1725 x 1721 pixels, FOV: 45 degrees:
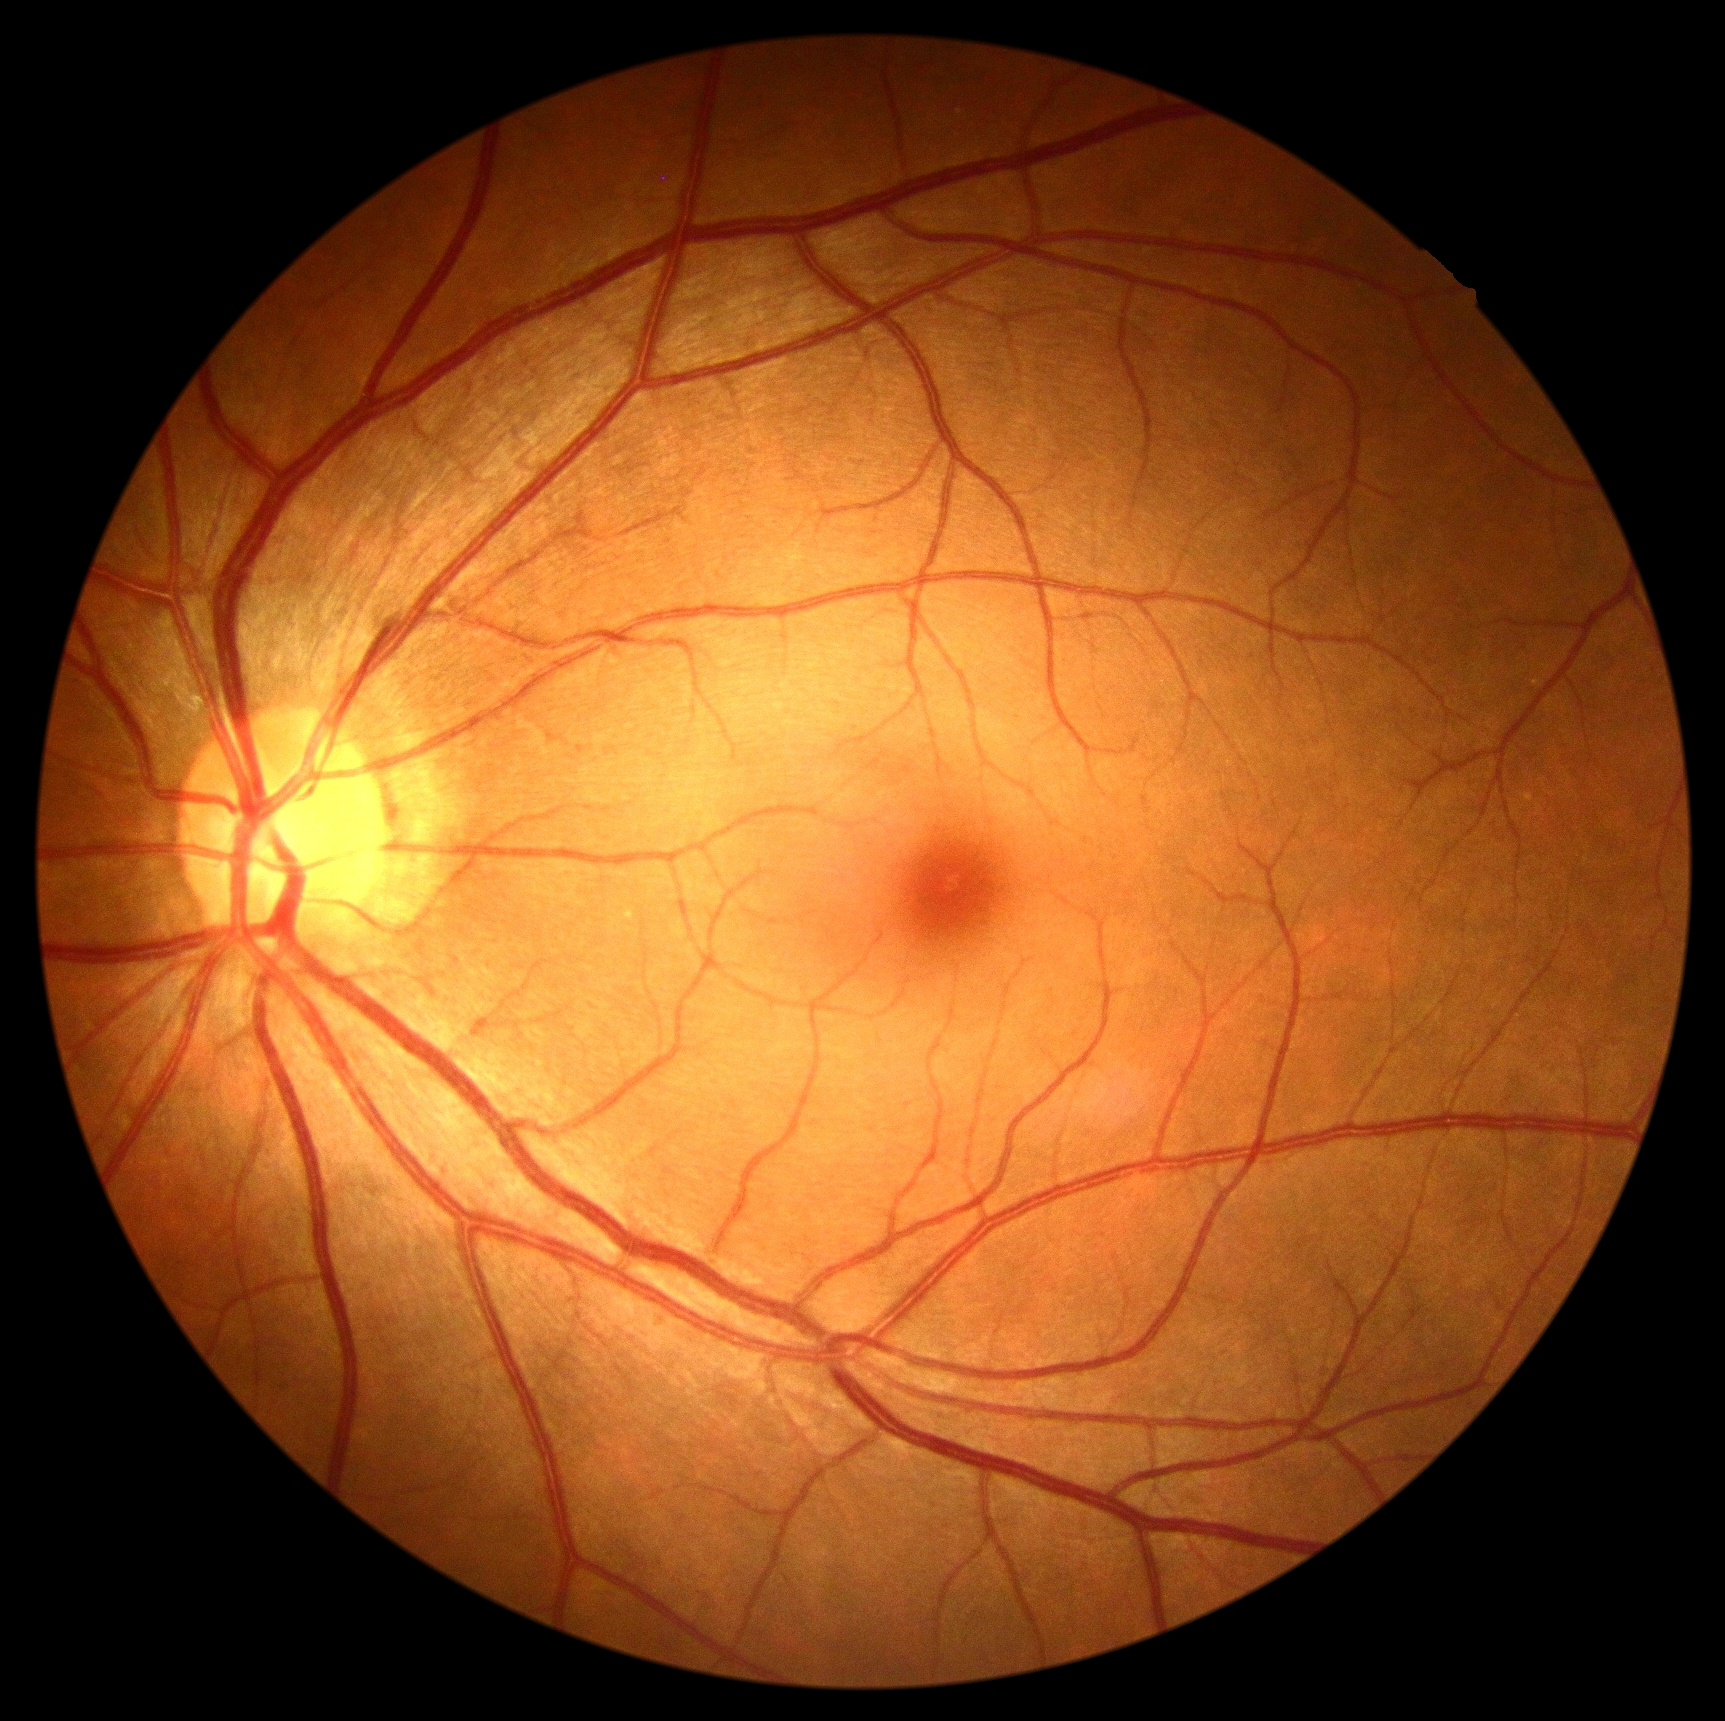
Findings:
* diabetic retinopathy: grade 0 (no apparent retinopathy)